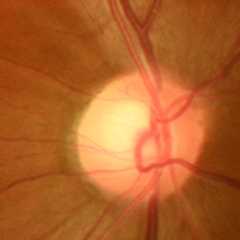

Glaucoma is present.
Early glaucomatous optic neuropathy.
Diagnostic criteria: glaucomatous retinal nerve fiber layer defects on red-free fundus photography without visual field defects.